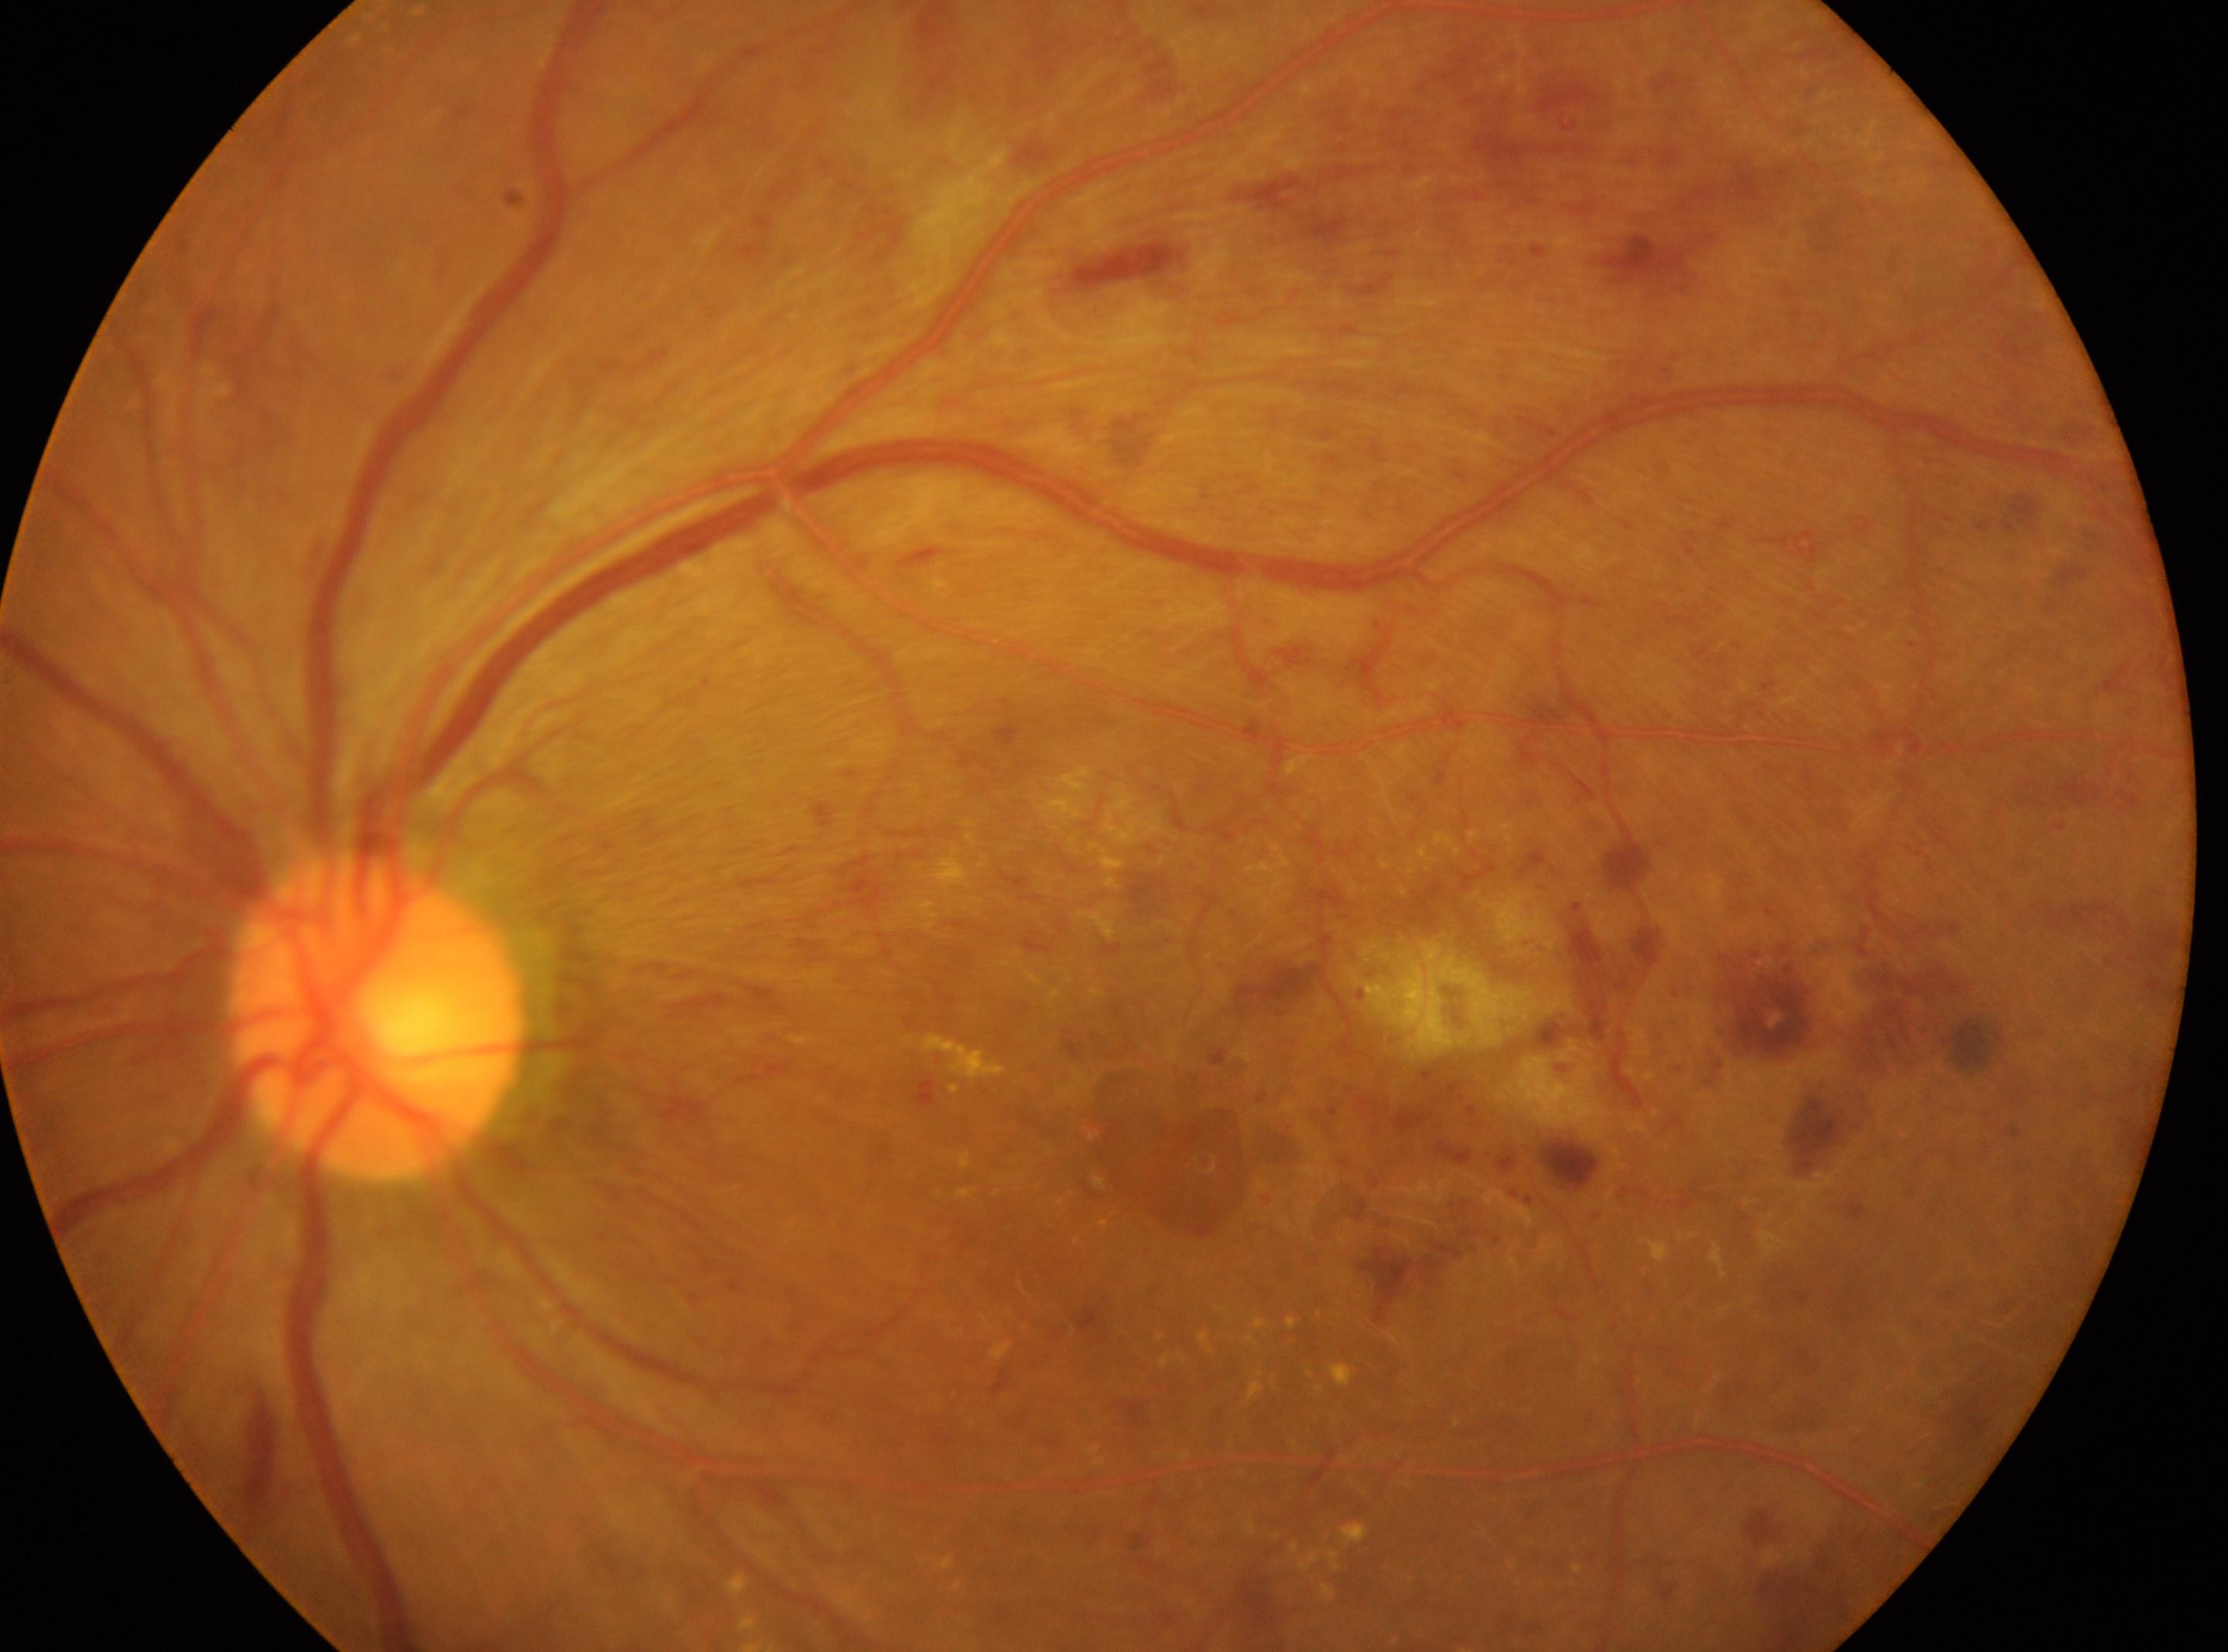
This is the oculus sinister. Optic disc: x=376, y=1018. Fovea located at x=1187, y=1134. DR: grade 3 (severe NPDR).